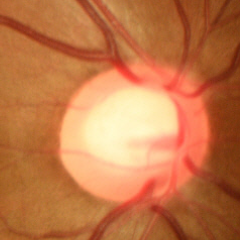 Optic disc photograph demonstrating no evidence of glaucoma.